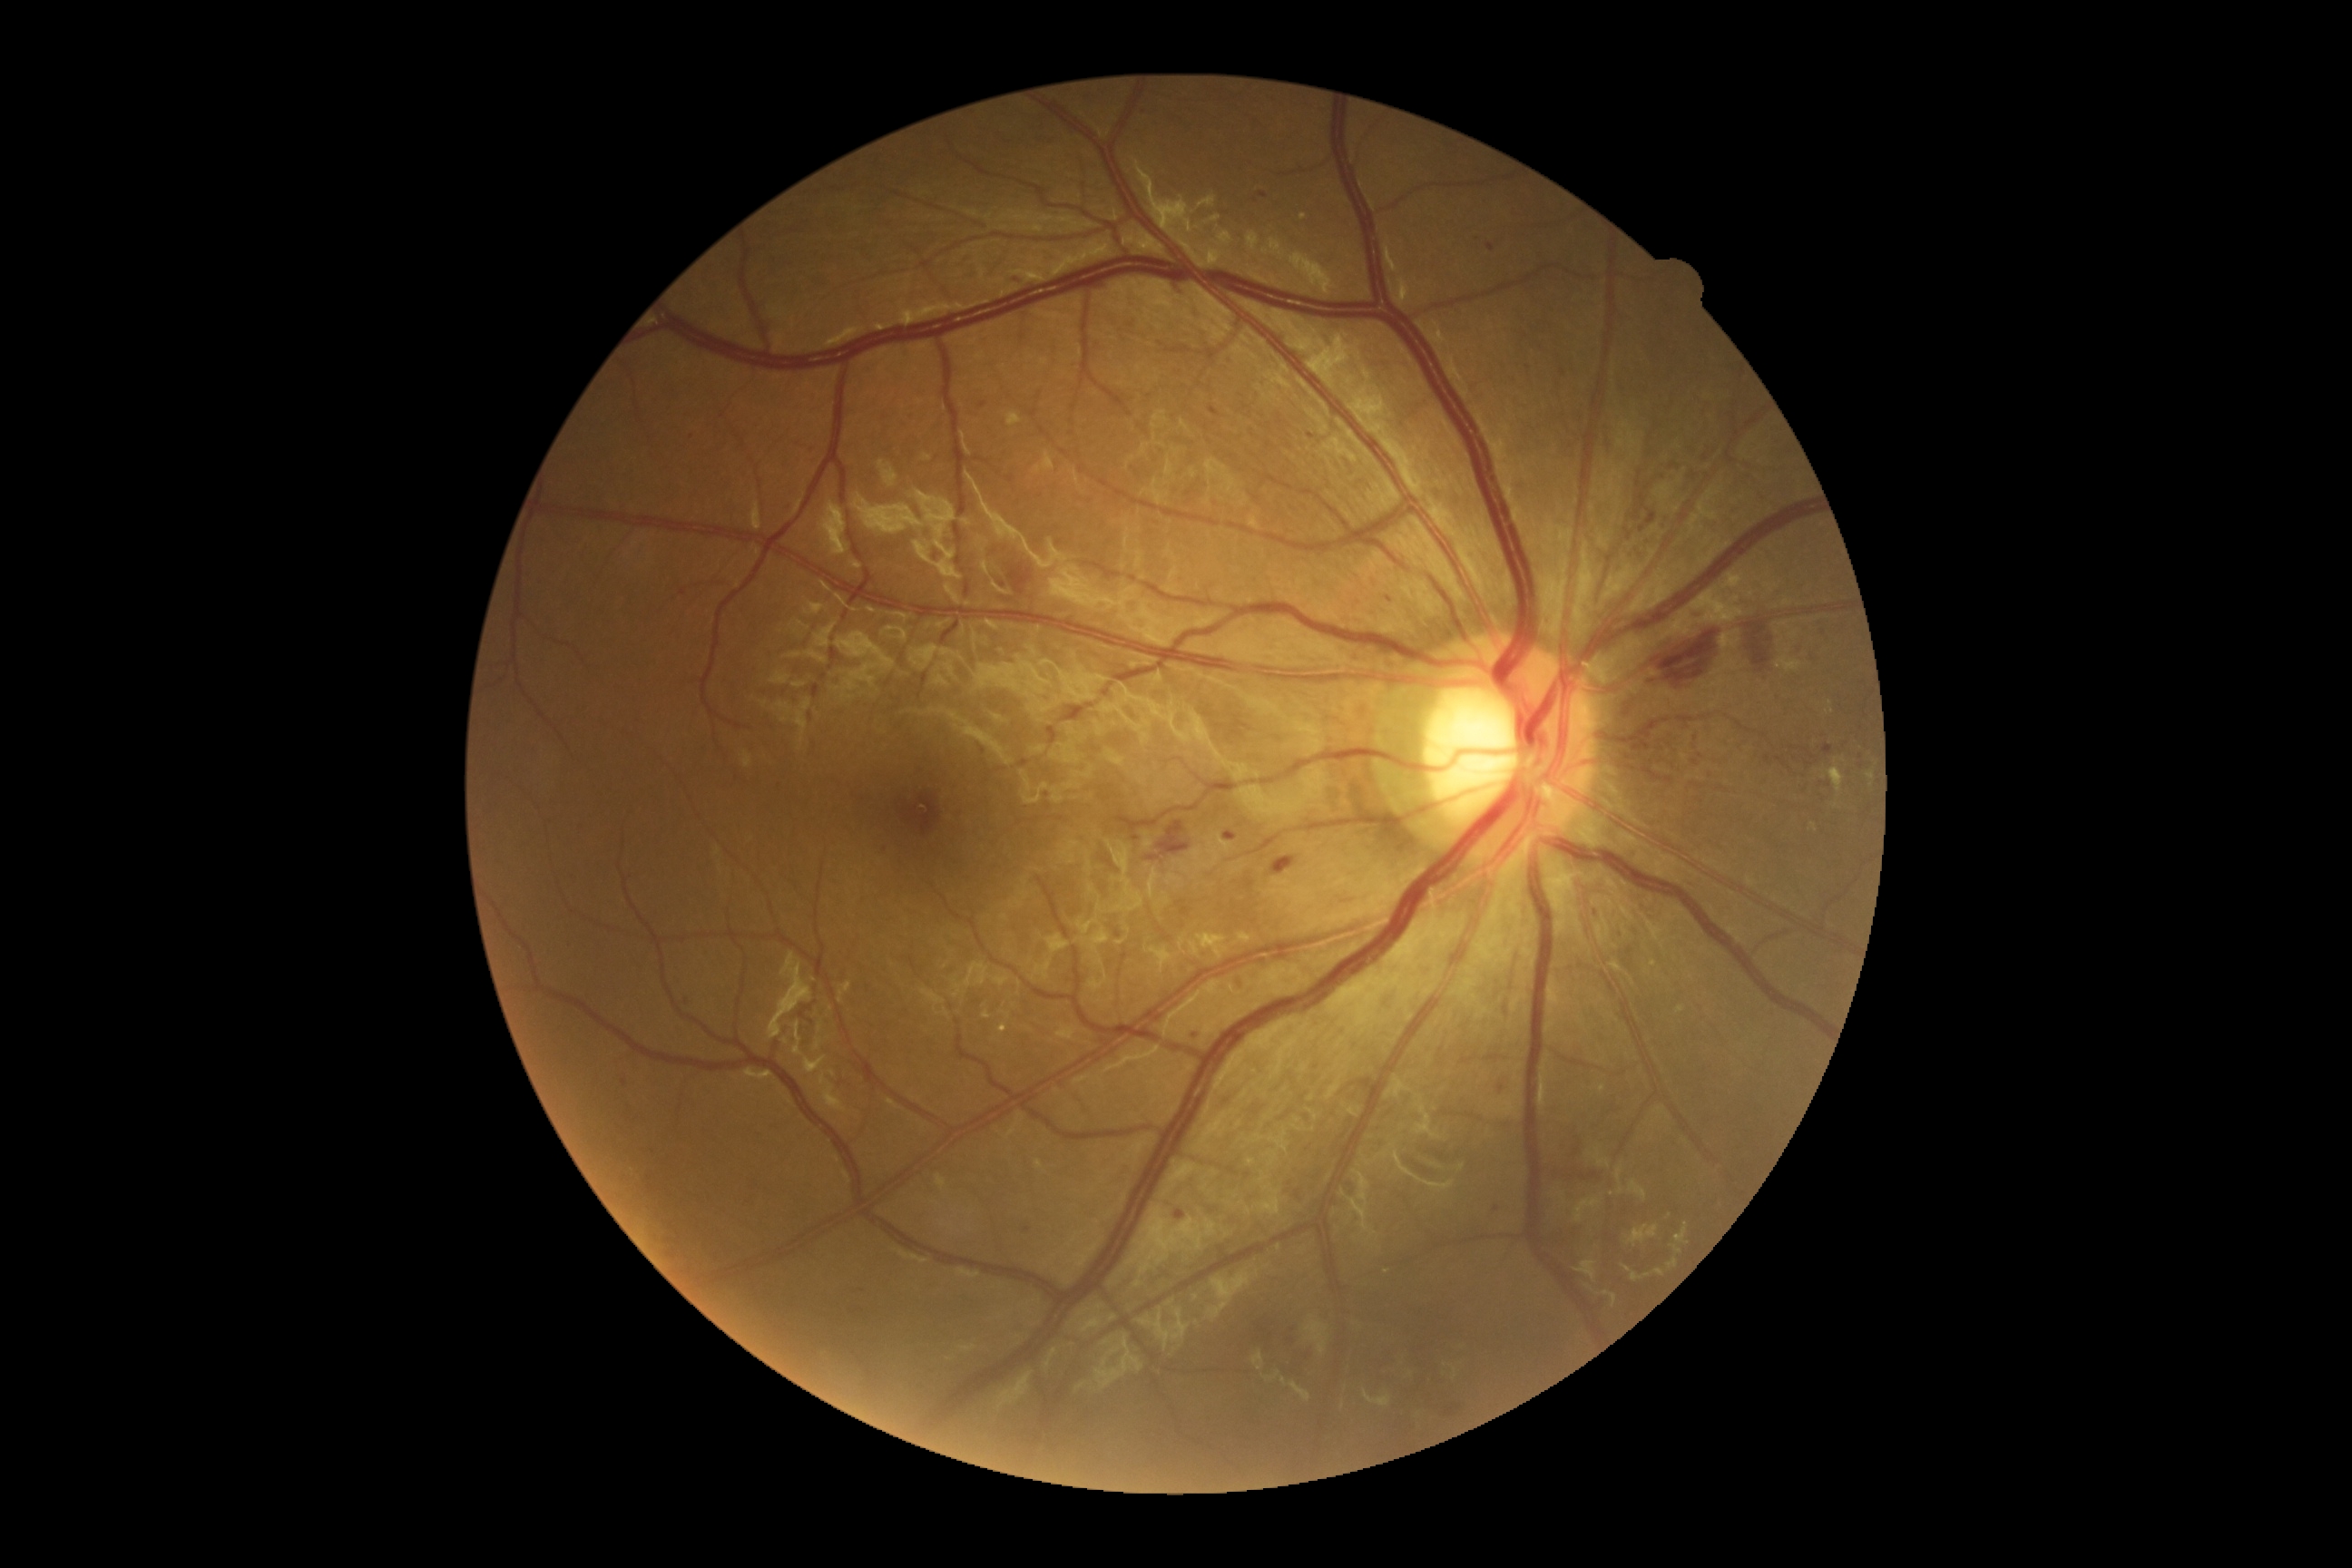 Diabetic retinopathy (DR) is moderate NPDR (grade 2).